2048 by 1536 pixels
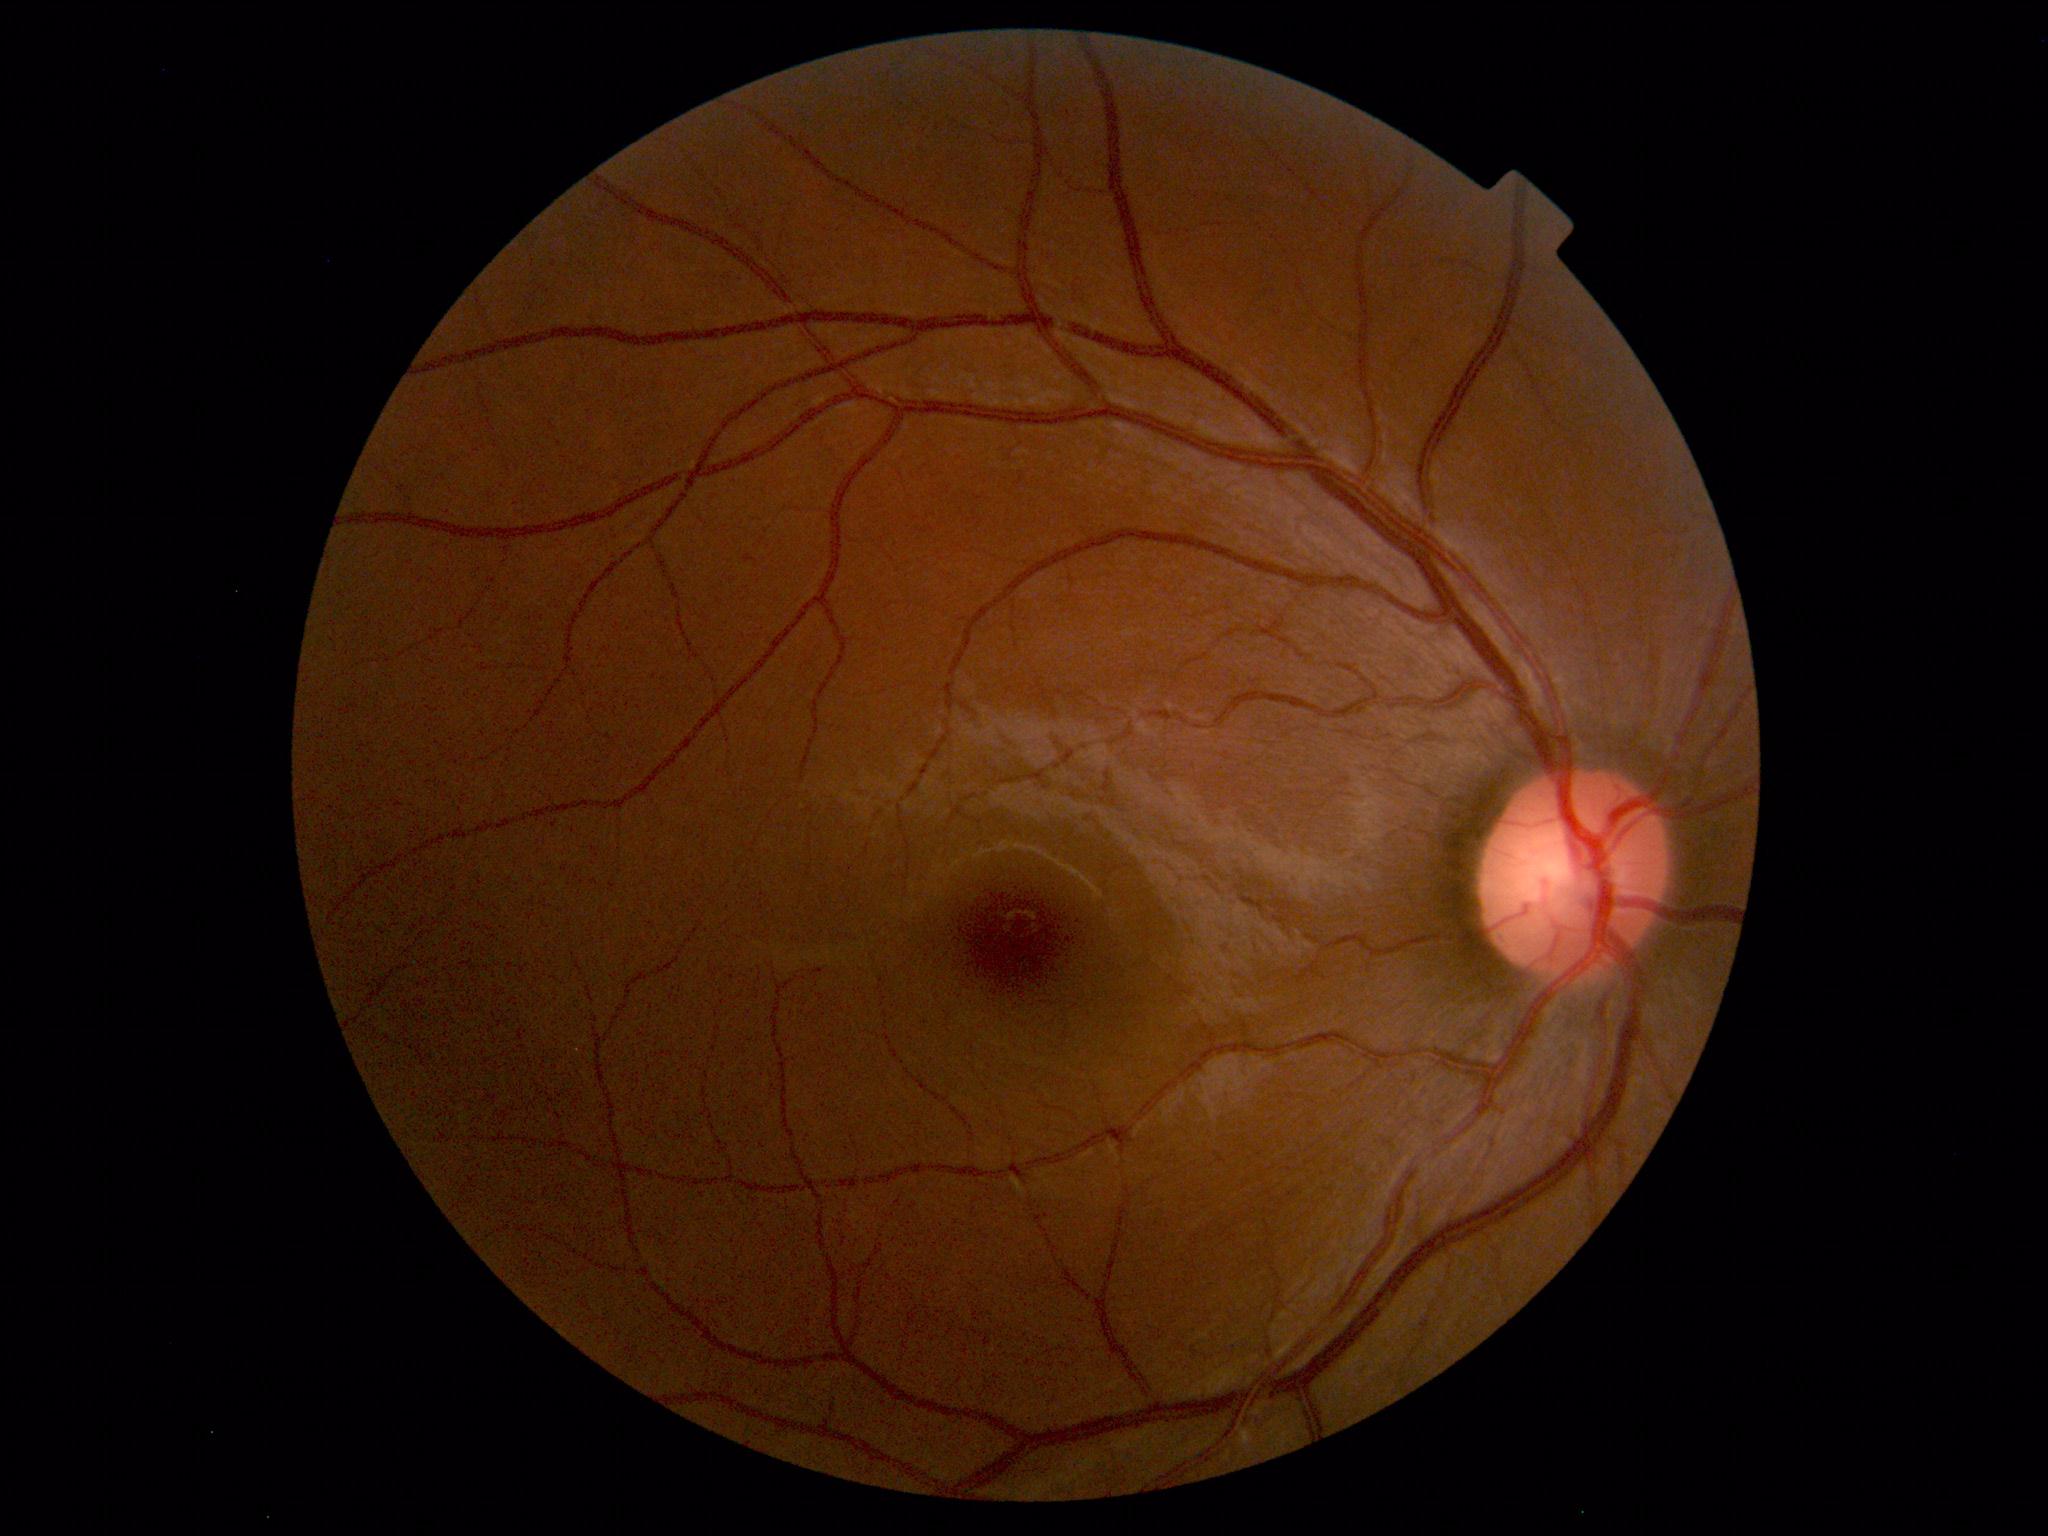 Impression: within normal limits.